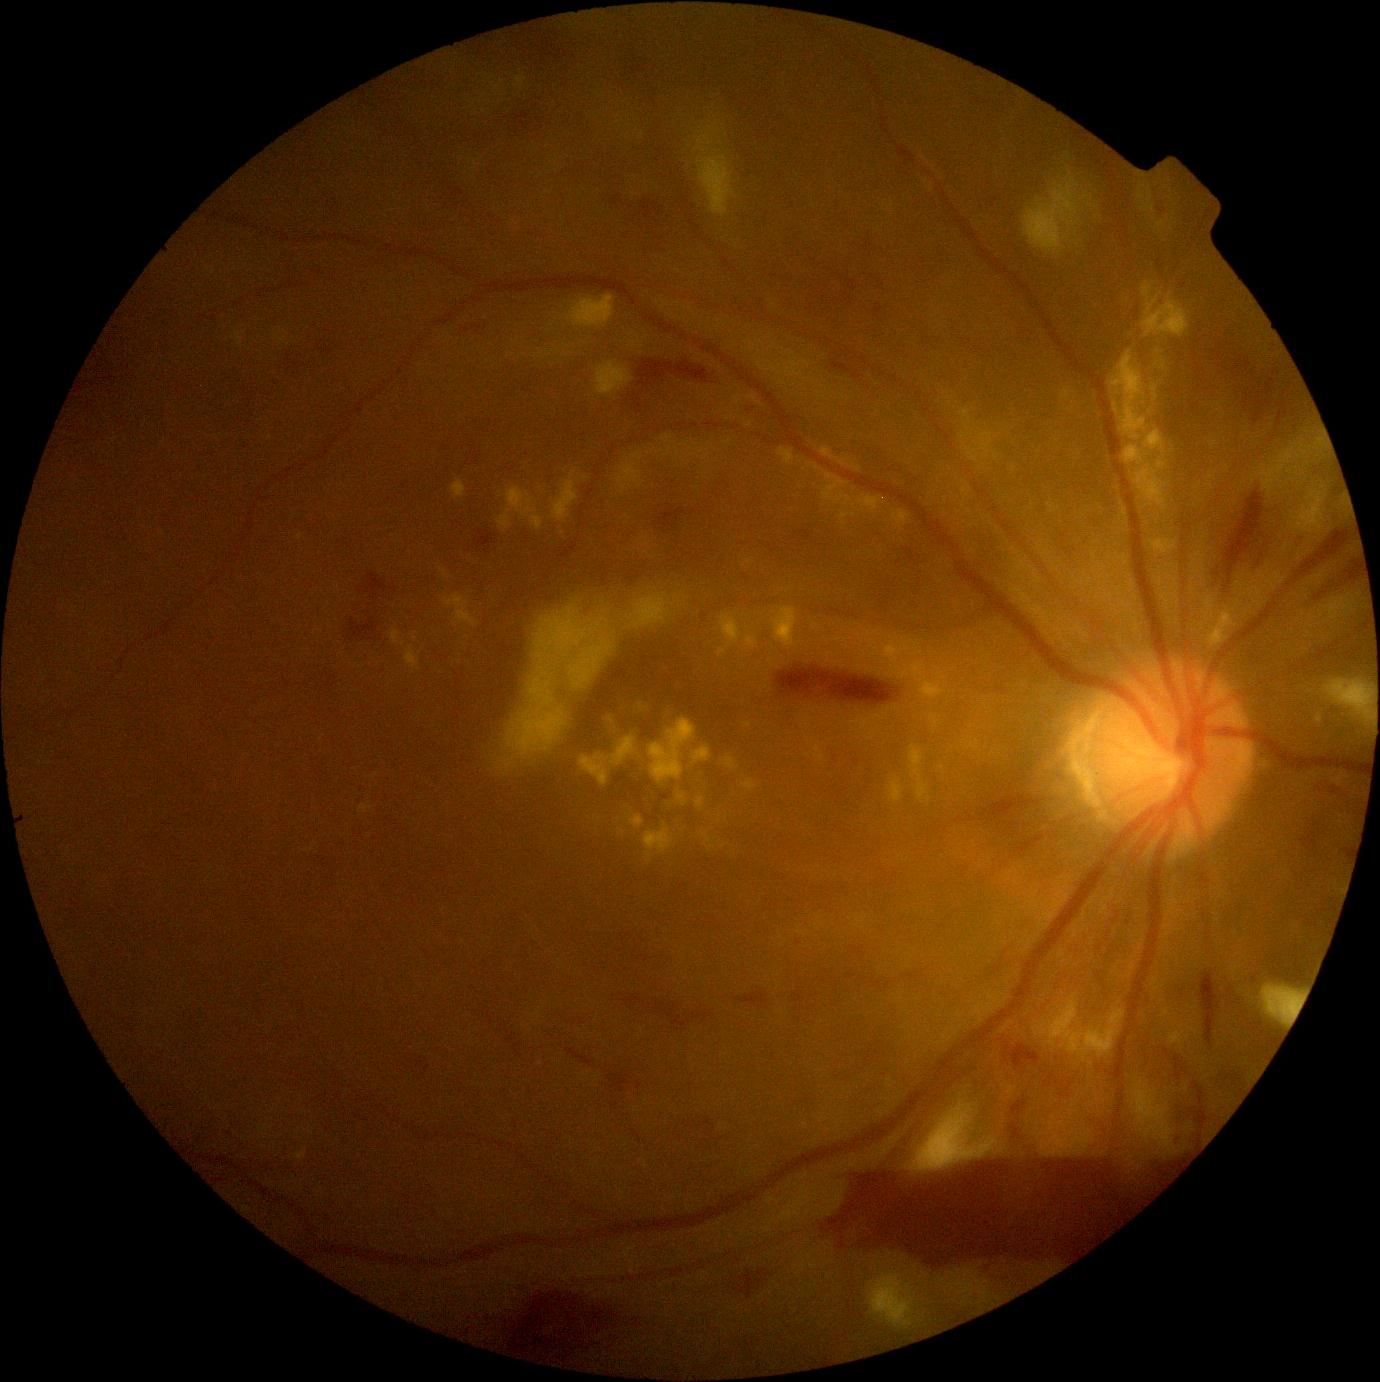
{"partial":true,"dr_grade":4,"lesions":{"he":[[1306,562,1363,607],[1256,521,1291,569],[734,1270,773,1299],[611,1070,632,1093],[1292,530,1353,584],[1165,1045,1211,1147],[776,666,900,705],[351,618,378,639],[1004,1120,1048,1161],[655,509,688,529],[368,572,388,597]],"ex":[[772,608,797,649],[660,447,672,457],[1122,430,1169,510],[919,680,944,700],[443,595,481,627],[637,703,645,711],[726,758,739,770],[630,816,645,829],[853,466,862,472],[745,723,753,728],[777,448,795,466],[506,487,544,532],[661,436,673,444],[1151,540,1177,556]],"ex_small_approx":[[1014,469],[460,663],[930,800],[1158,351],[1320,719]],"se":[[710,123,718,130],[1138,187,1145,200],[870,1274,917,1328],[1292,492,1326,534],[911,1105,1000,1173],[1142,196,1156,215],[1262,469,1279,492],[1323,680,1373,712],[595,362,633,397],[1132,1091,1176,1158]],"se_small_approx":[[1378,696],[1300,458],[1303,447],[1378,702],[1305,453]]}}